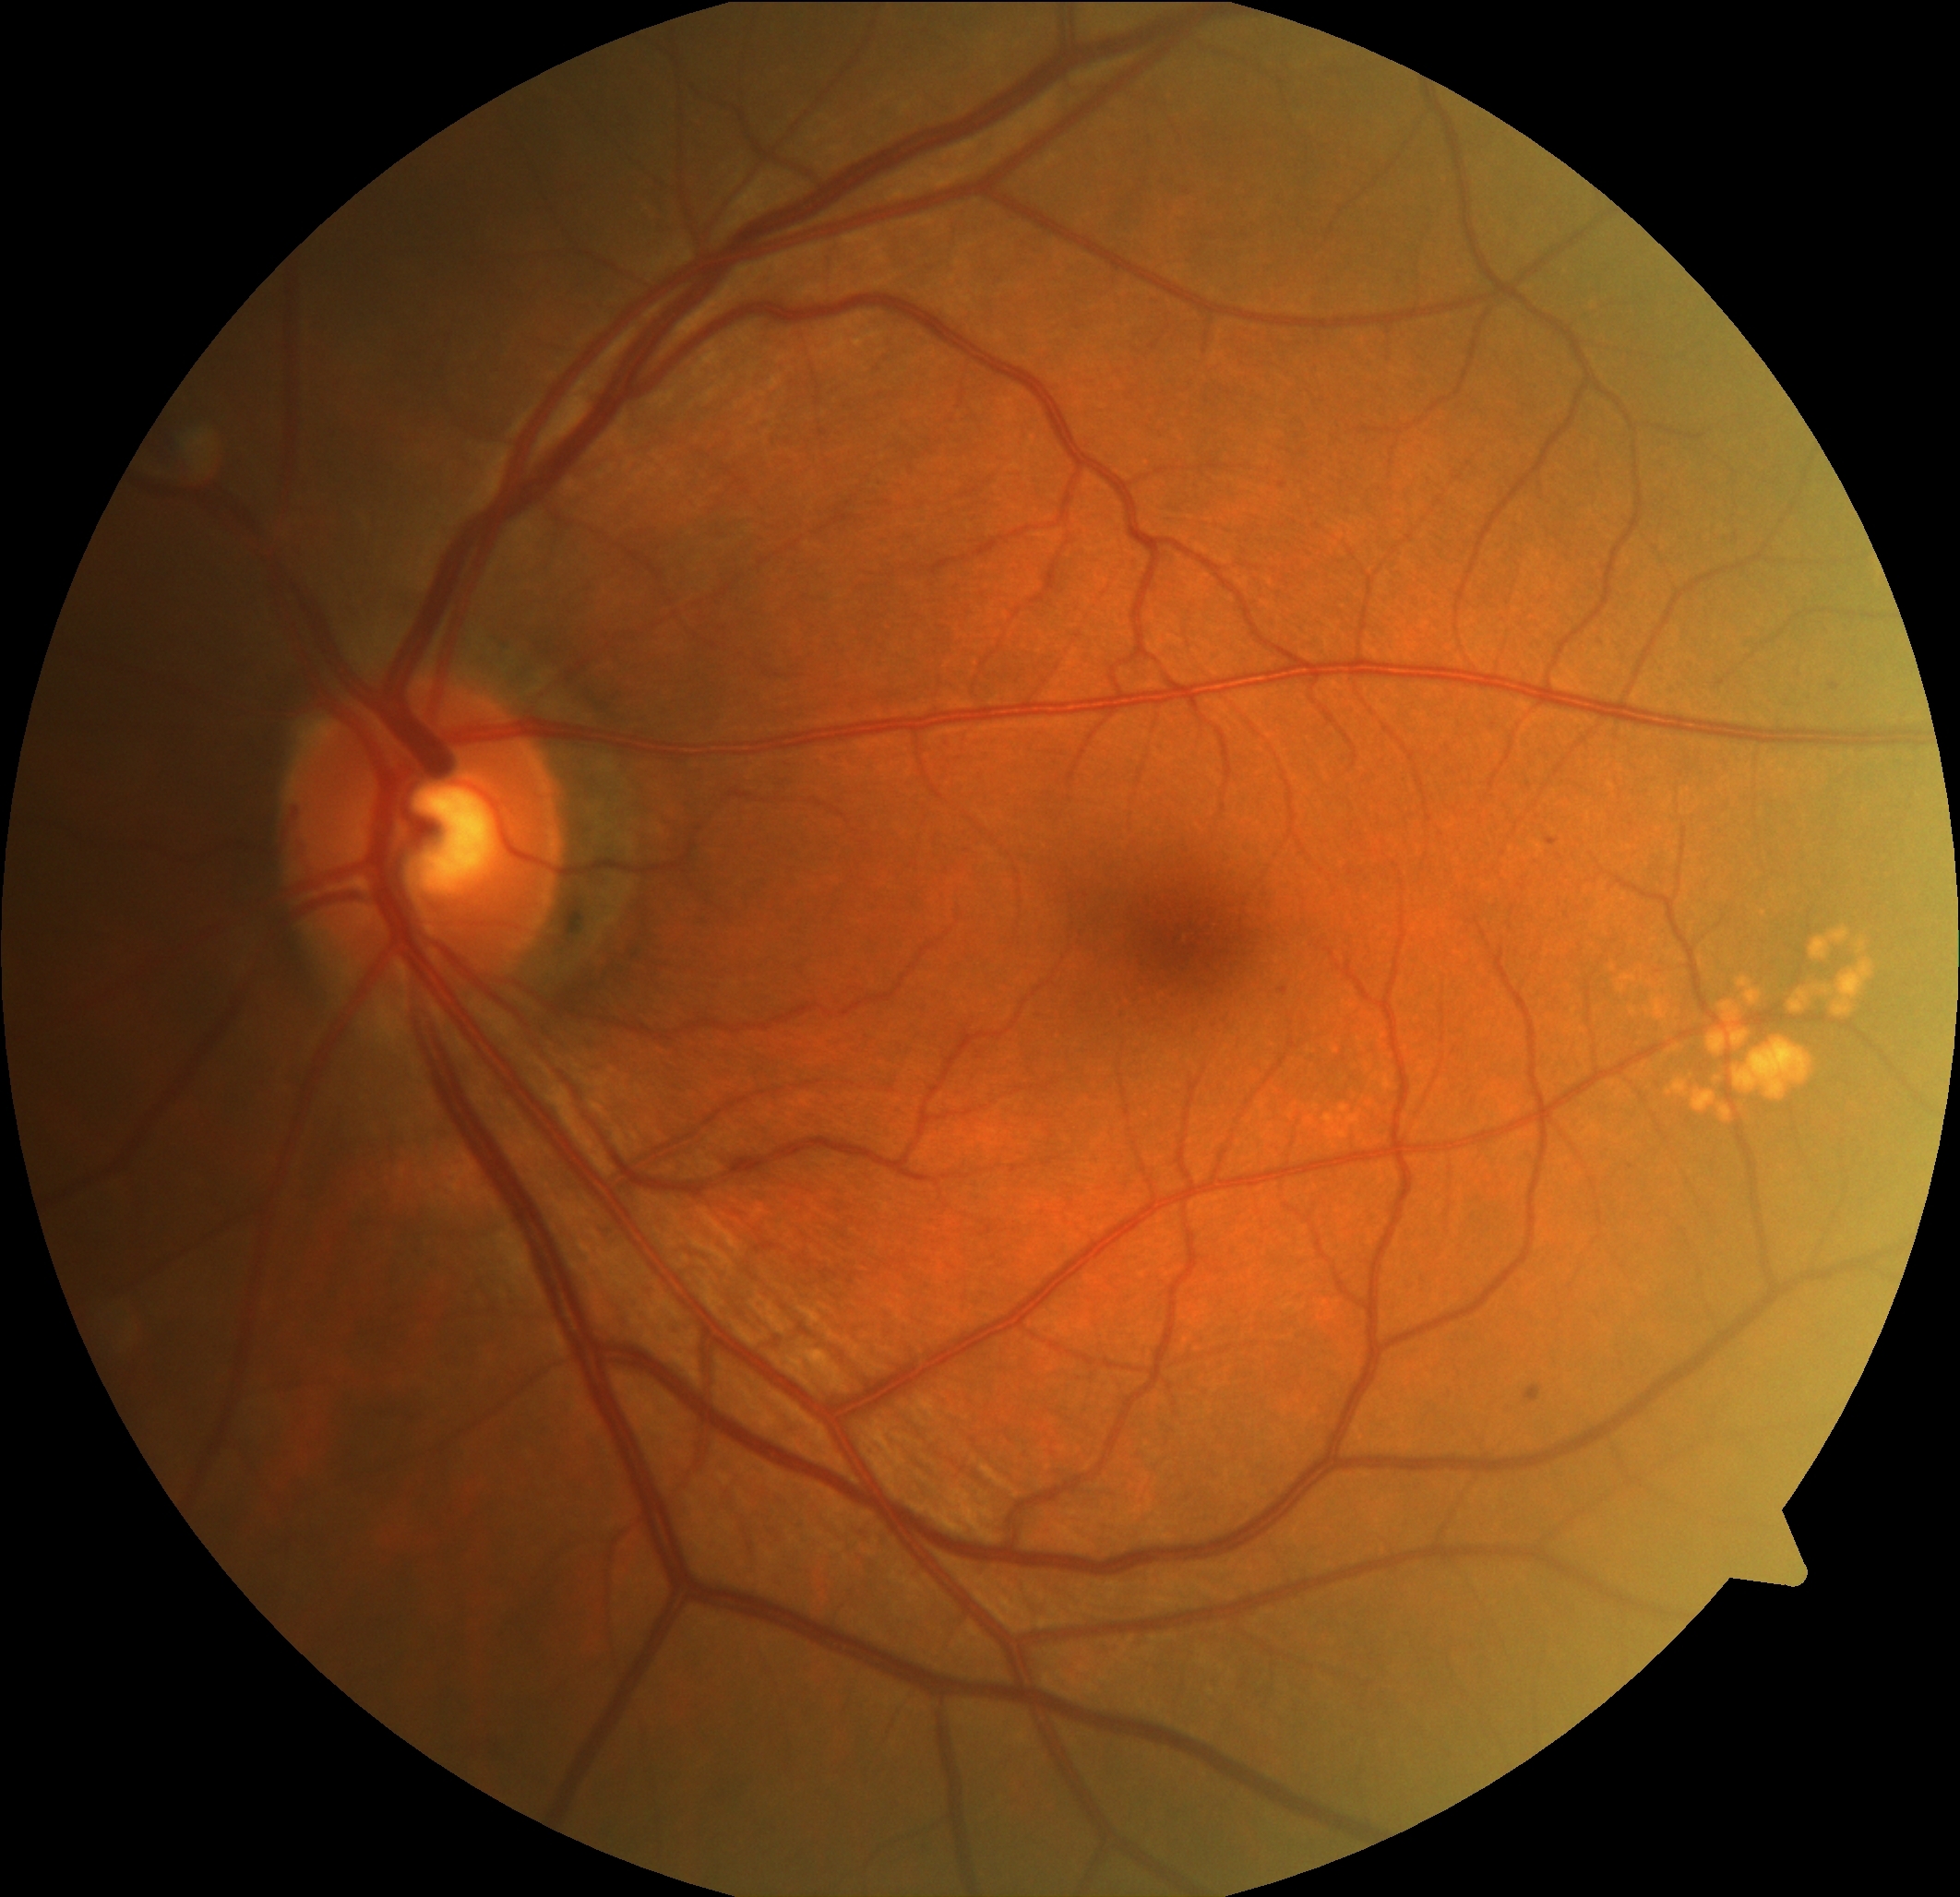

DR grade is 1
HEs: none detected
EXs: none detected
SEs: none detected
MAs: rect(1524, 1386, 1542, 1402) | rect(1546, 839, 1559, 846) | rect(1285, 978, 1305, 997) | rect(1831, 684, 1840, 691)
Smaller MAs around 1283:486